Acquired with a Canon CR-1. Retinal fundus photograph. FOV: 45 degrees: 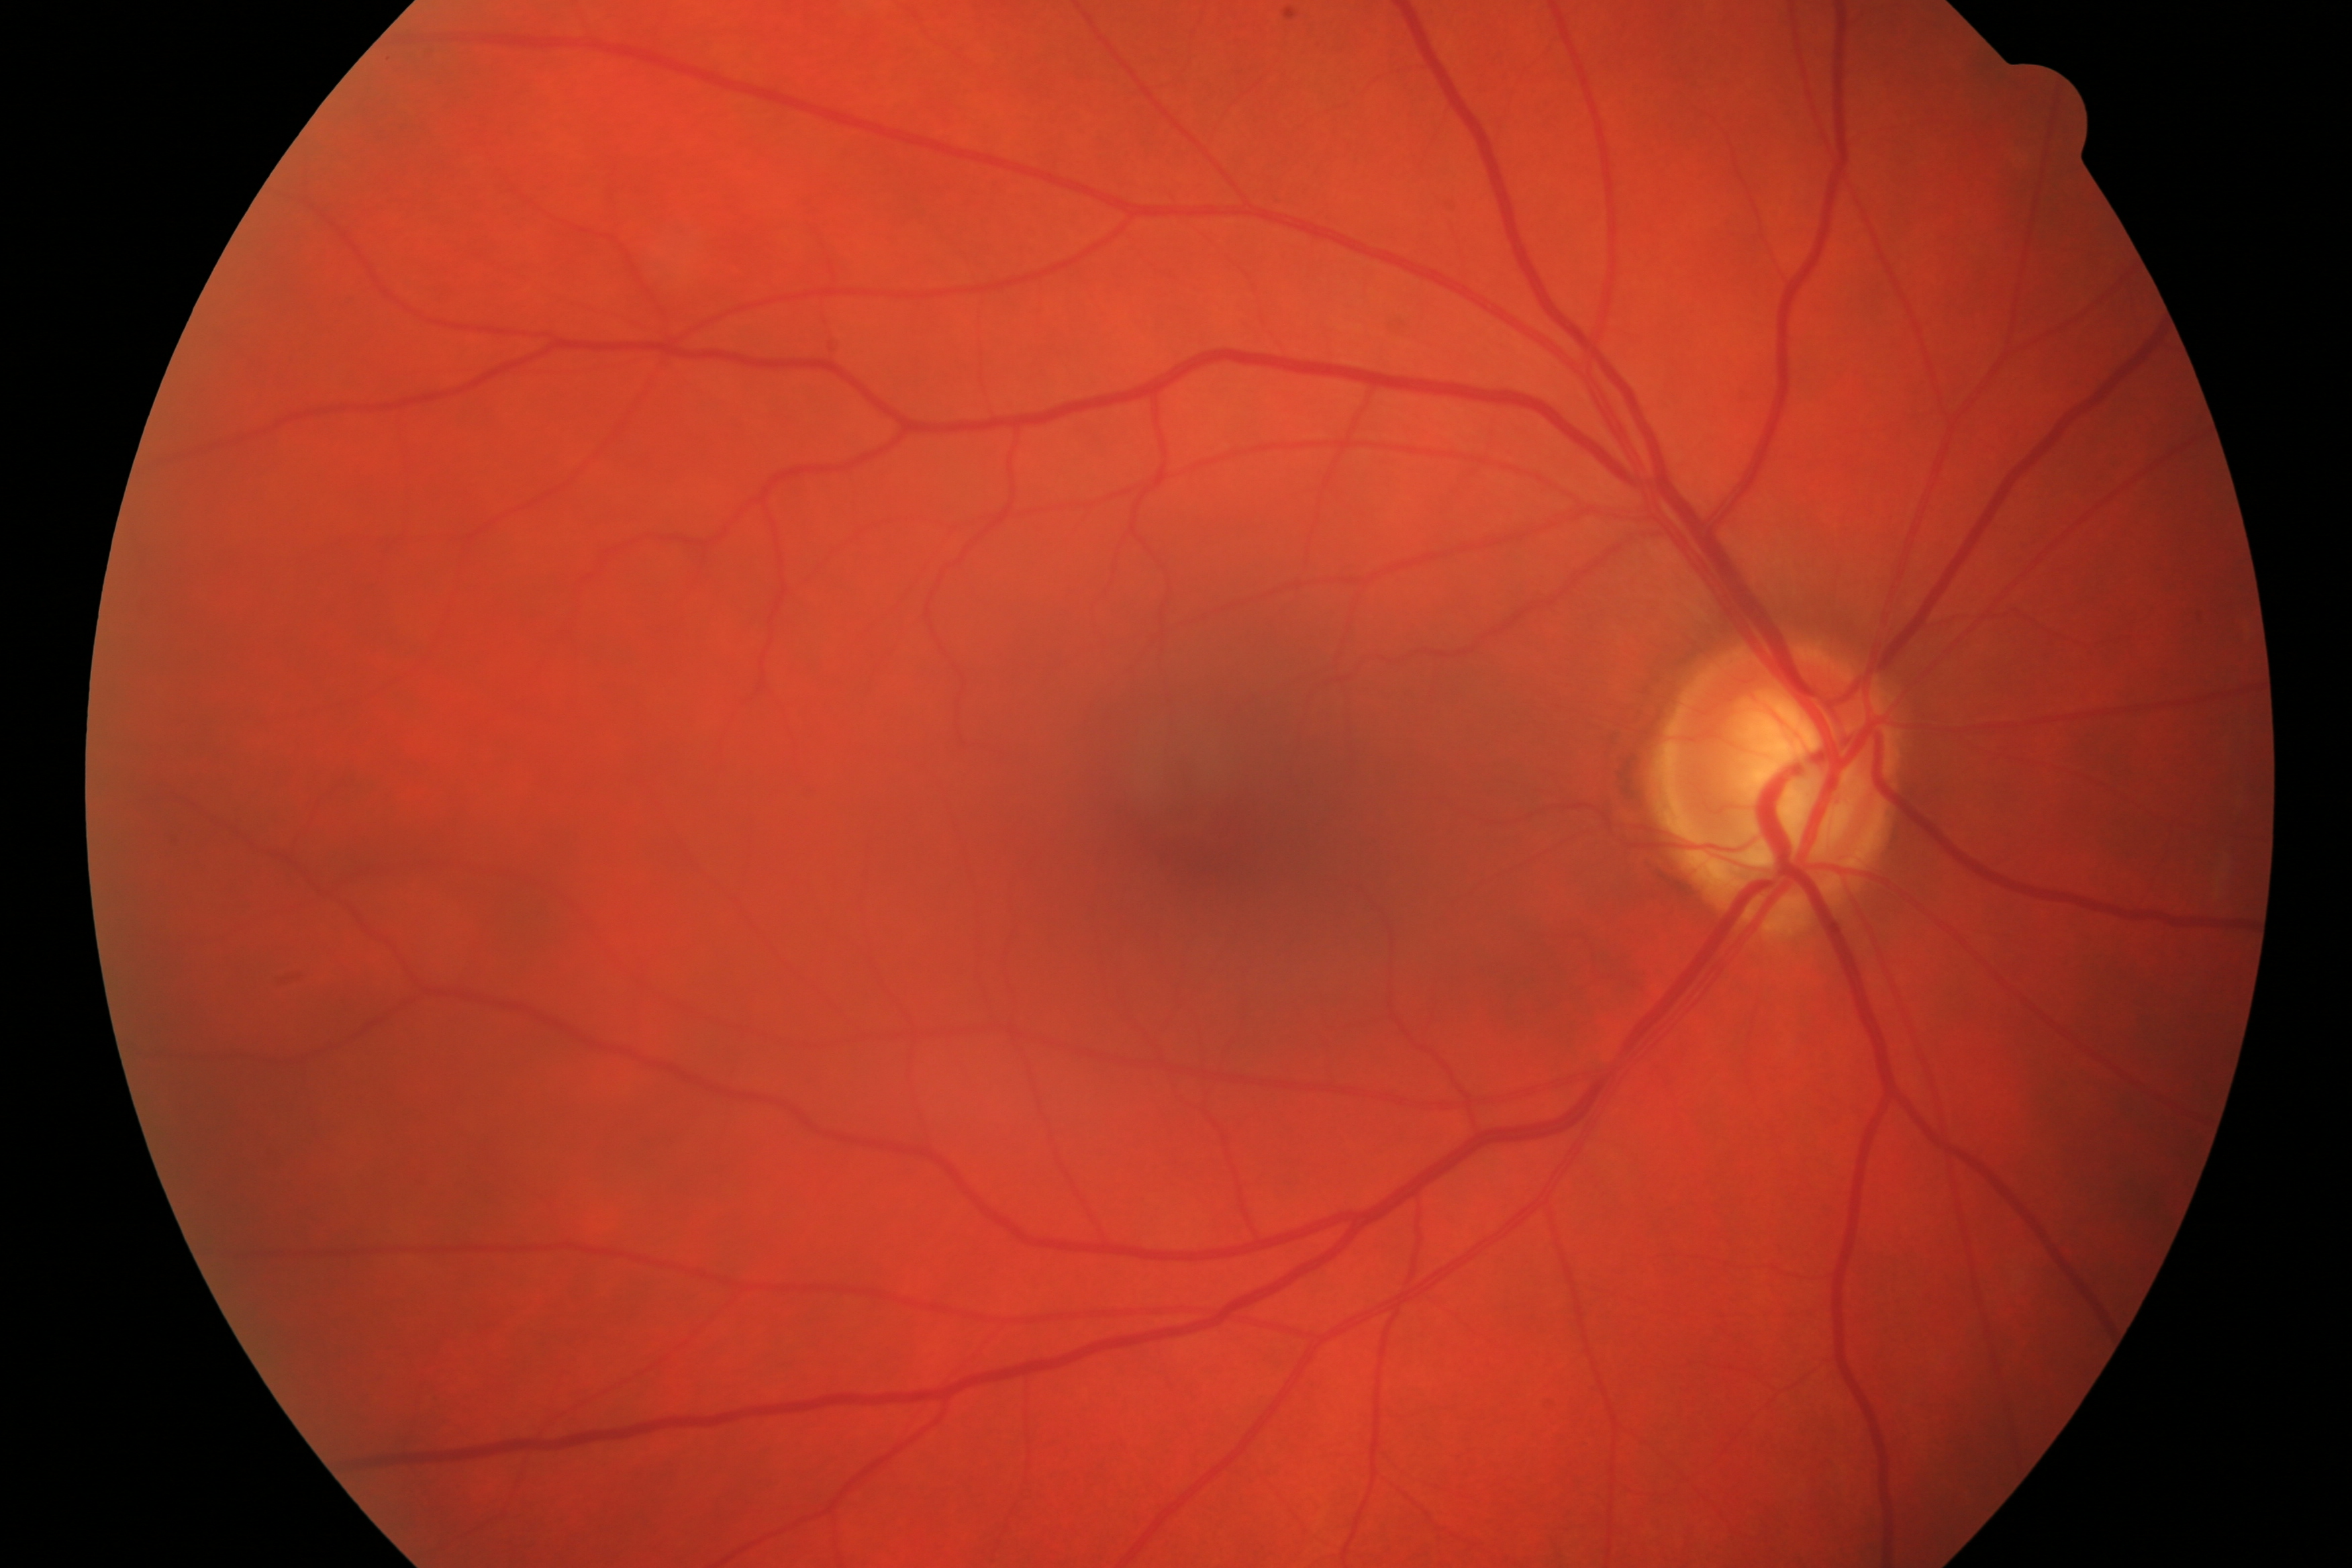 Findings consistent with glaucomatous damage.